Color fundus image, 45° FOV:
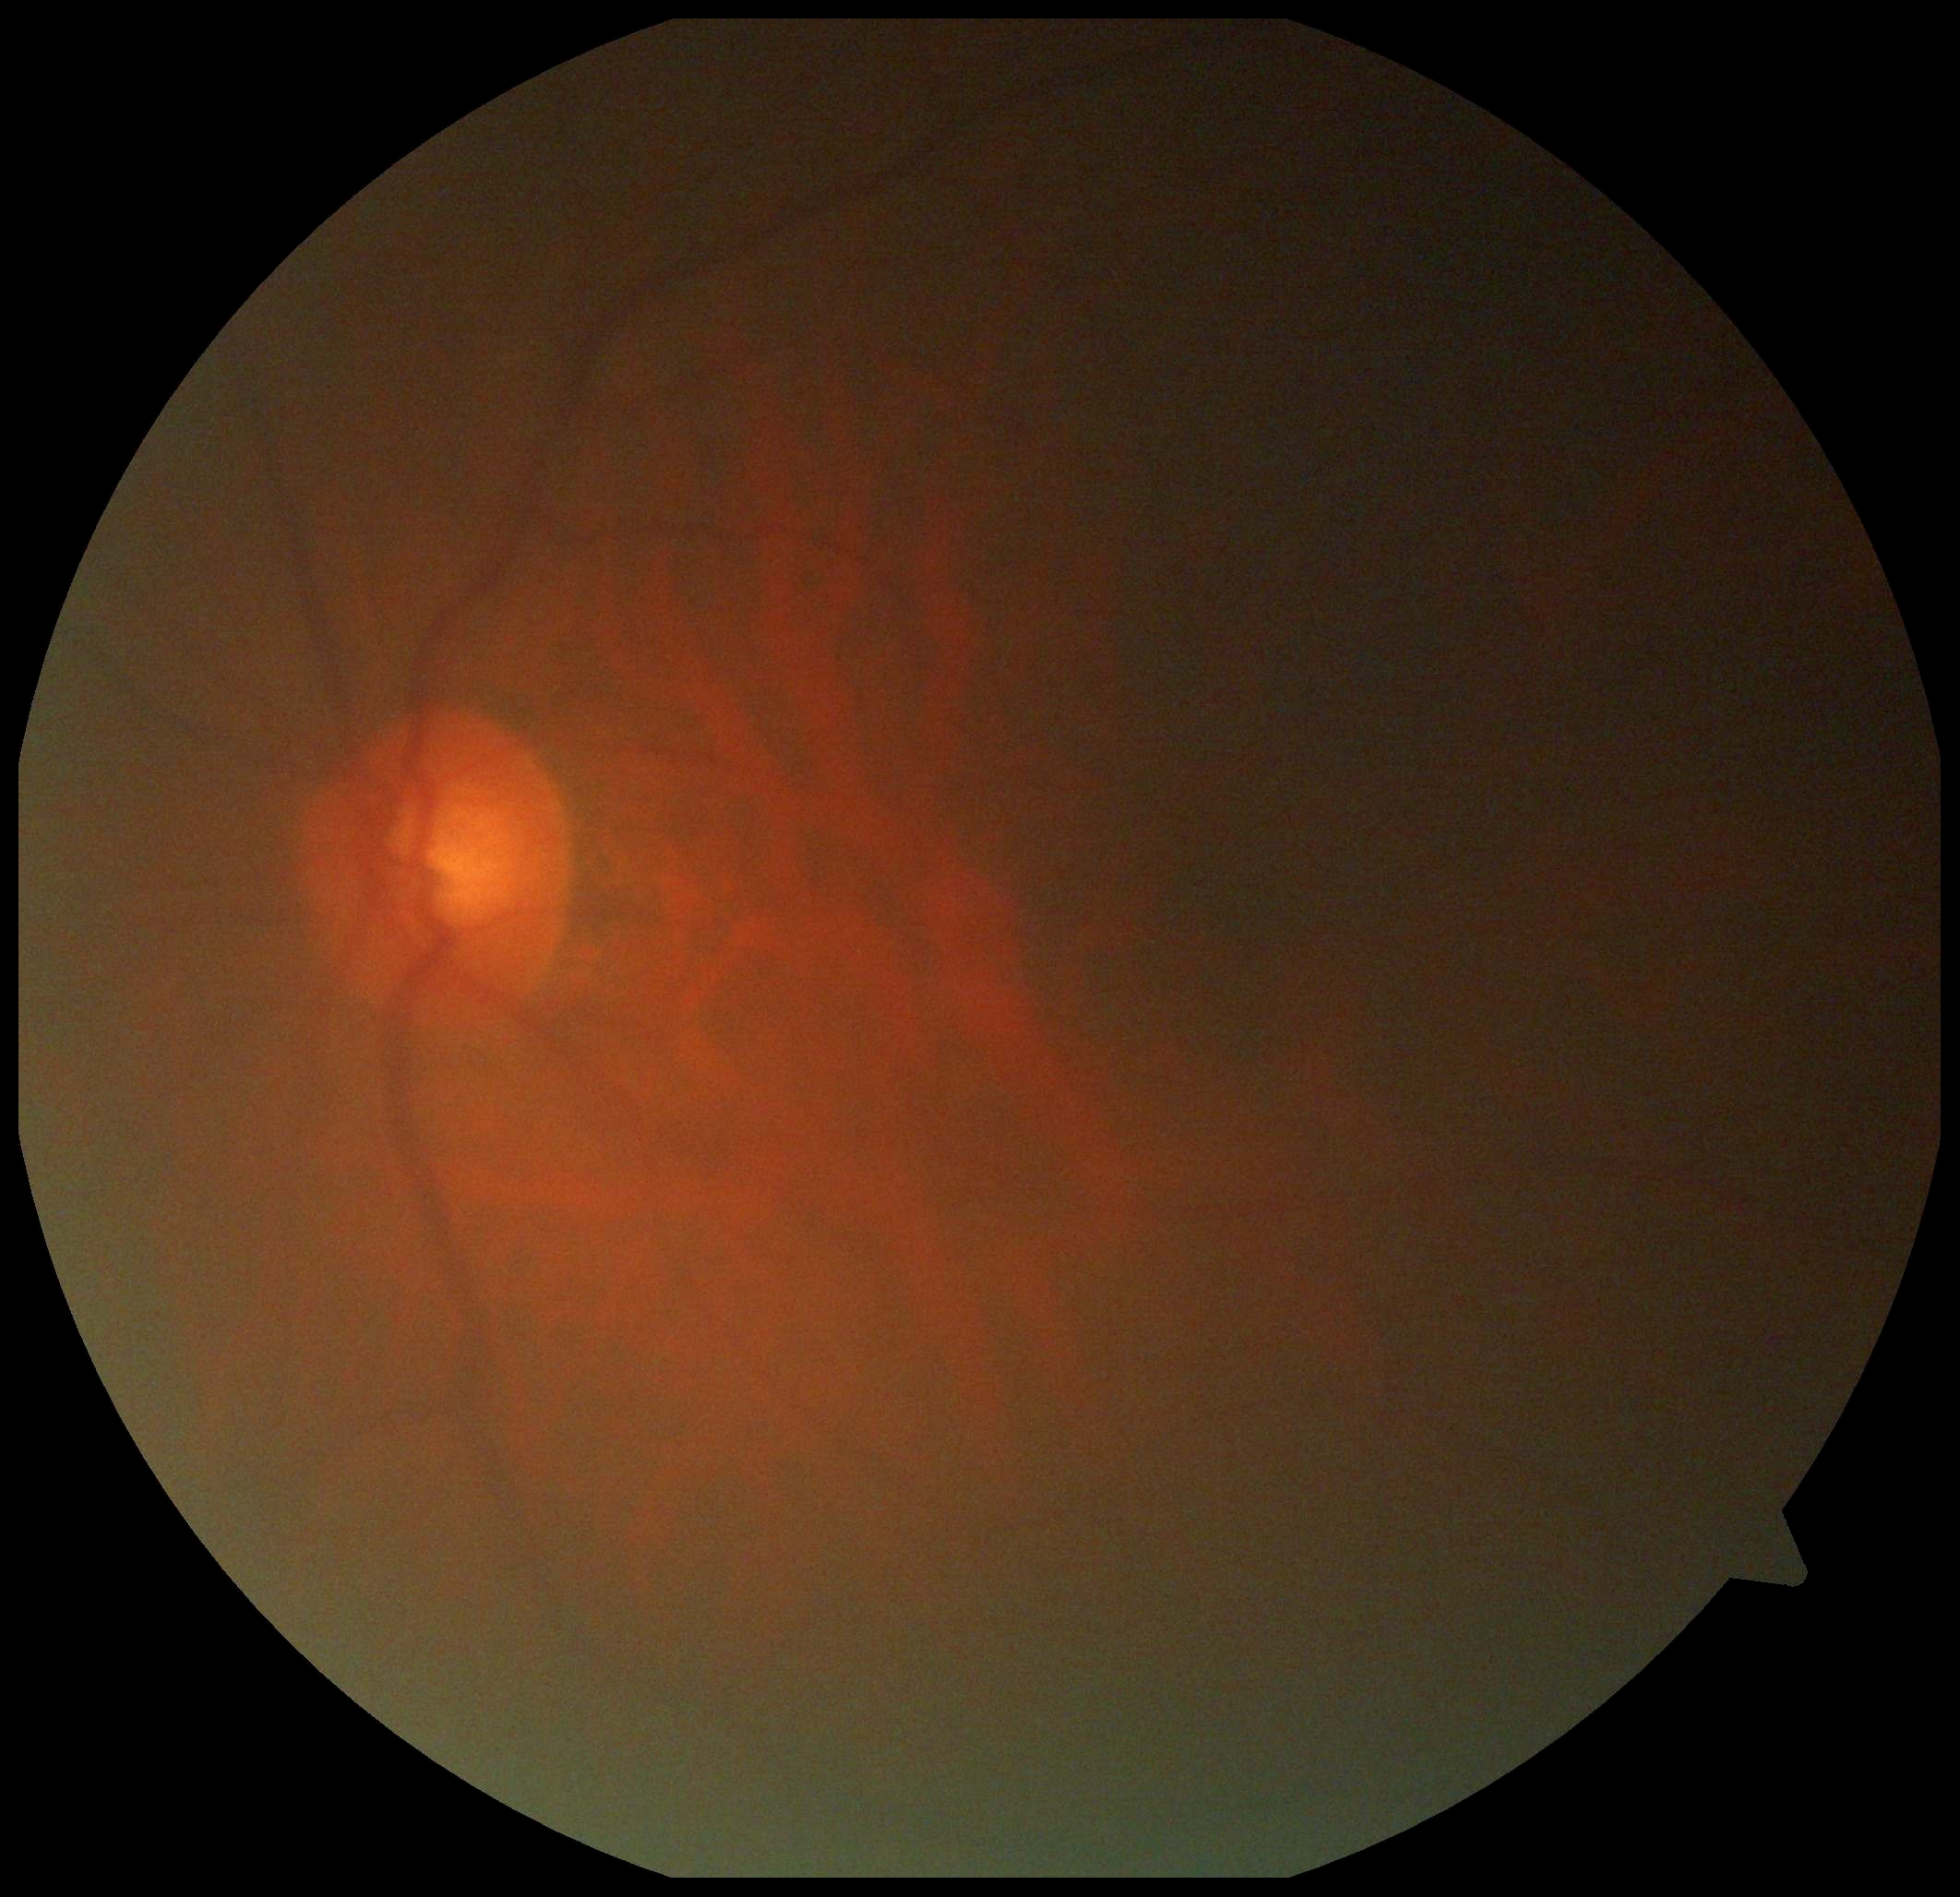

DR stage: grade 0 (no apparent retinopathy).